Optic disc region crop: 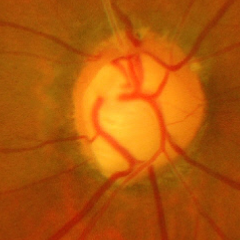

Assessment = advanced glaucoma.